Camera: Nidek AFC-330. Color fundus image.
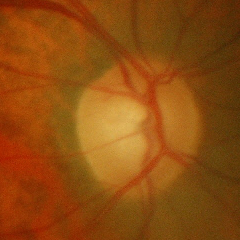

Findings consistent with early glaucomatous optic neuropathy.